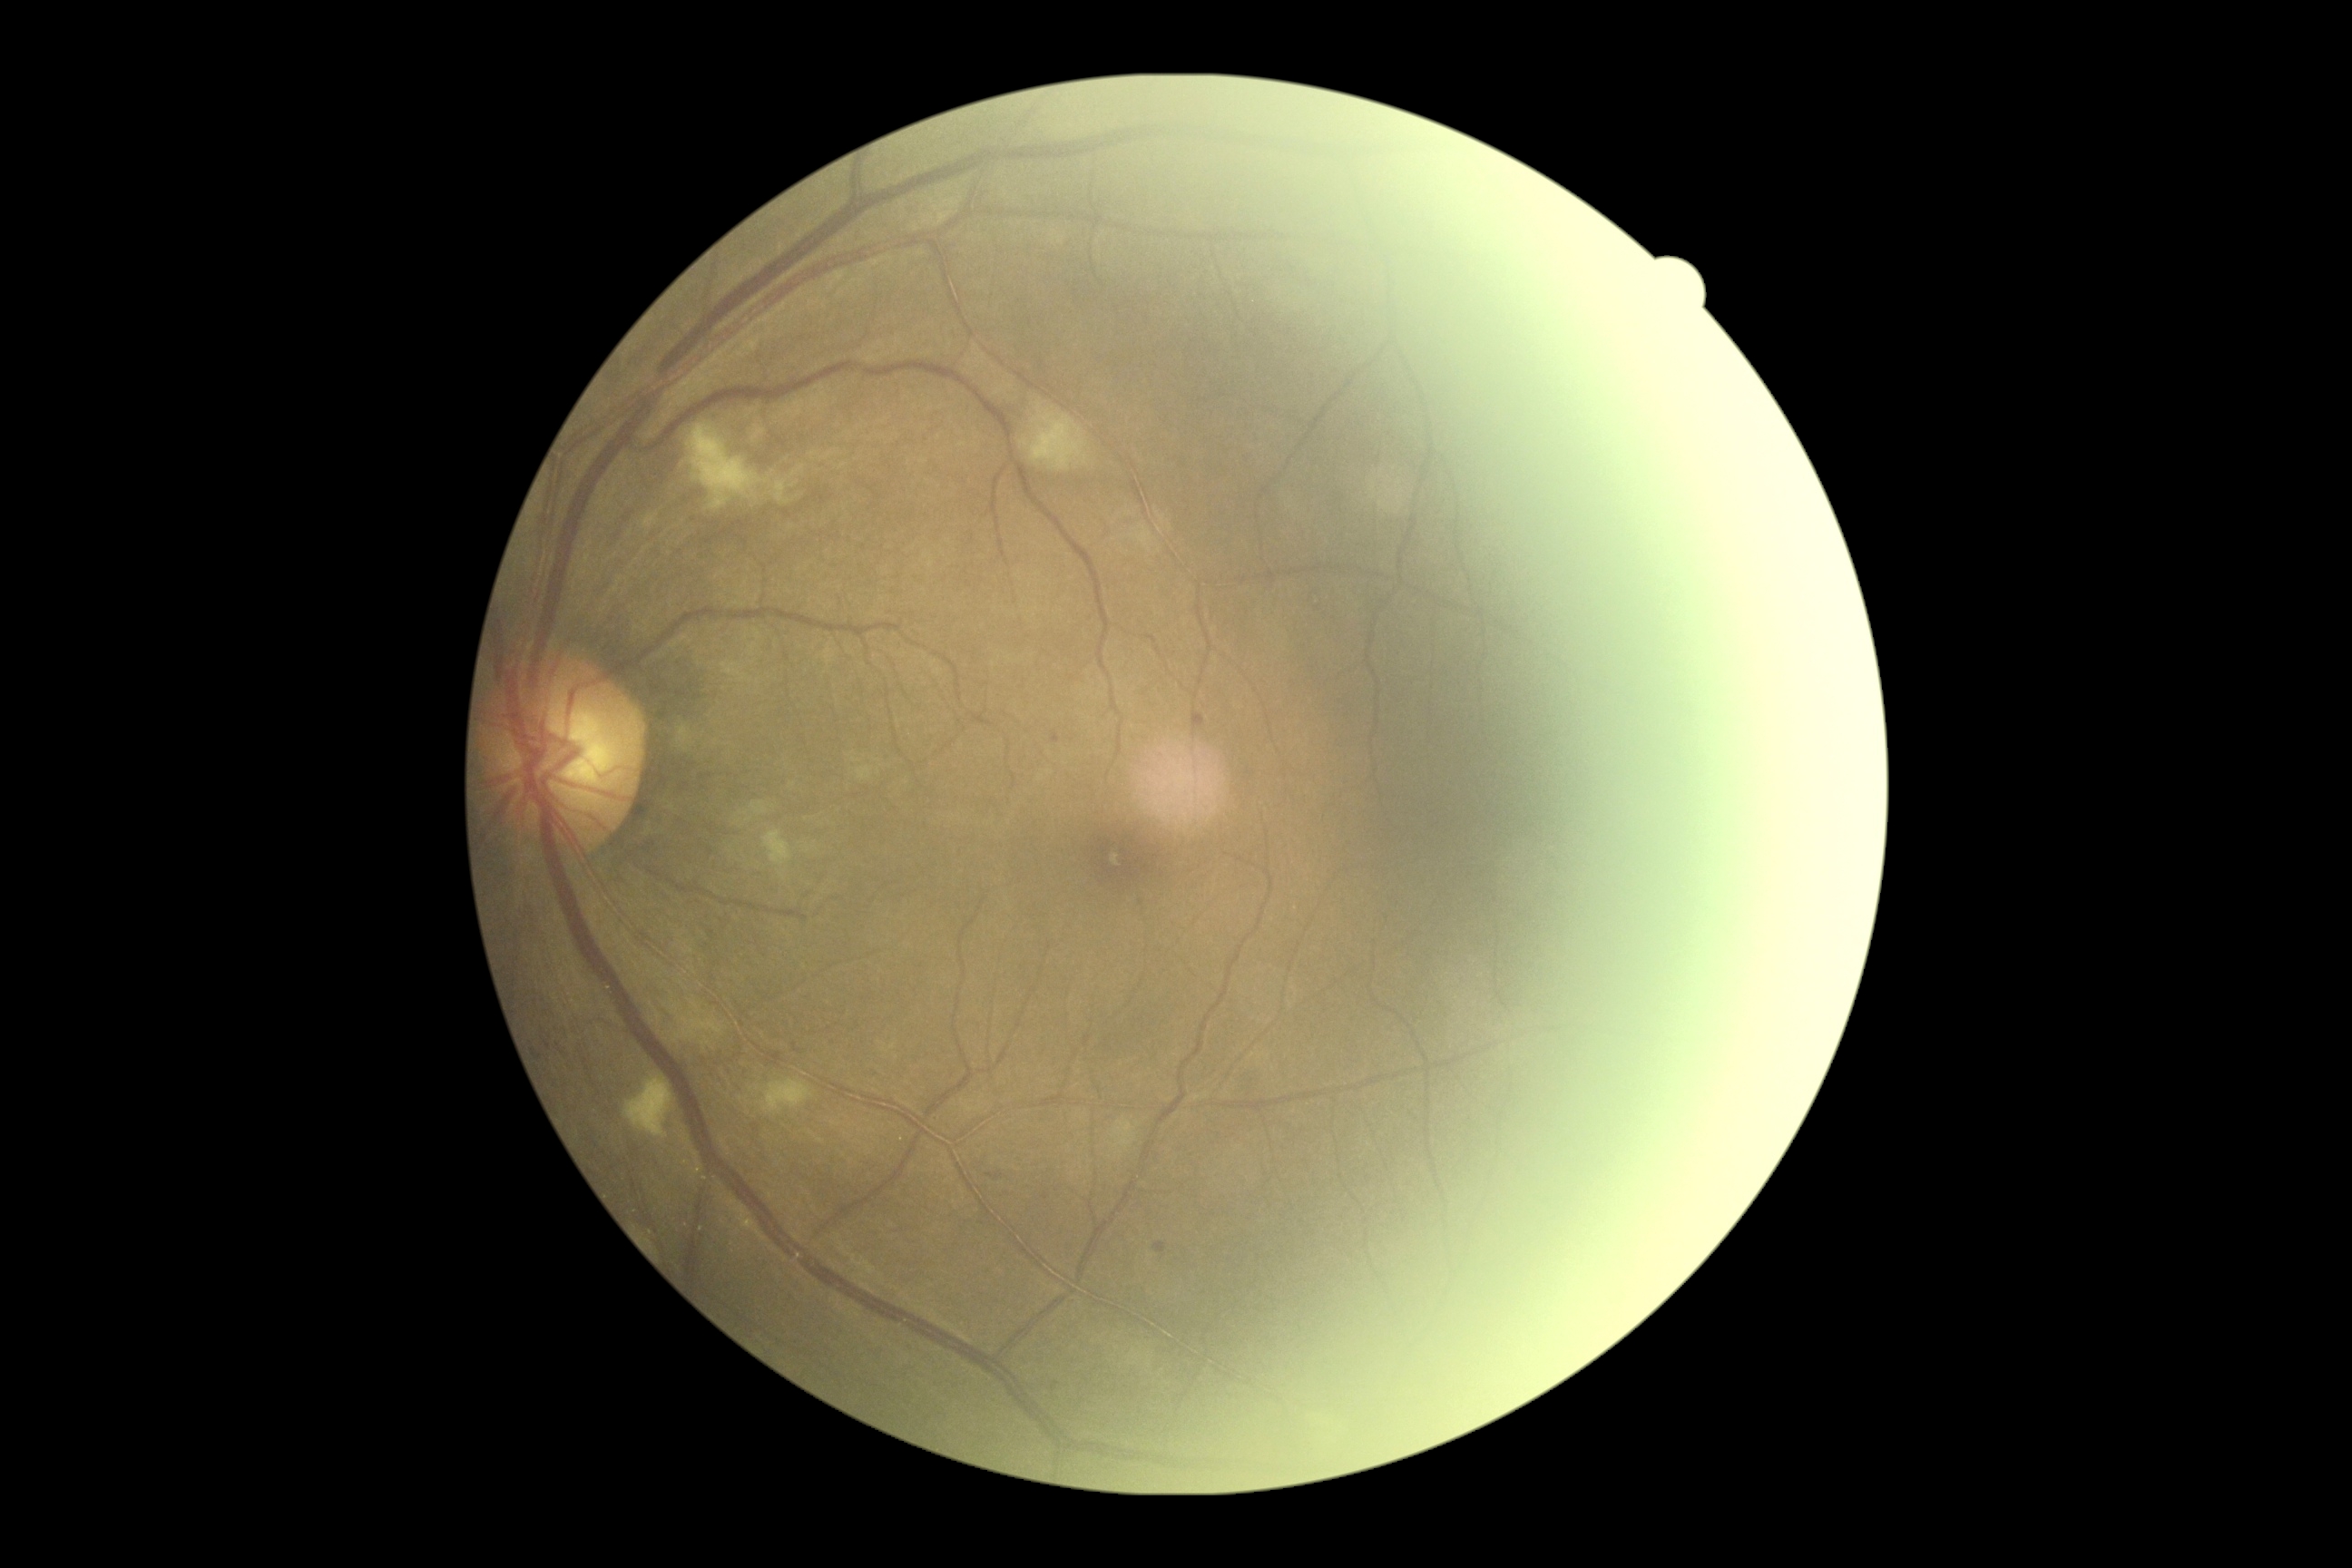
retinopathy grade = 2 (moderate NPDR)